Modified Davis classification · 45° field of view:
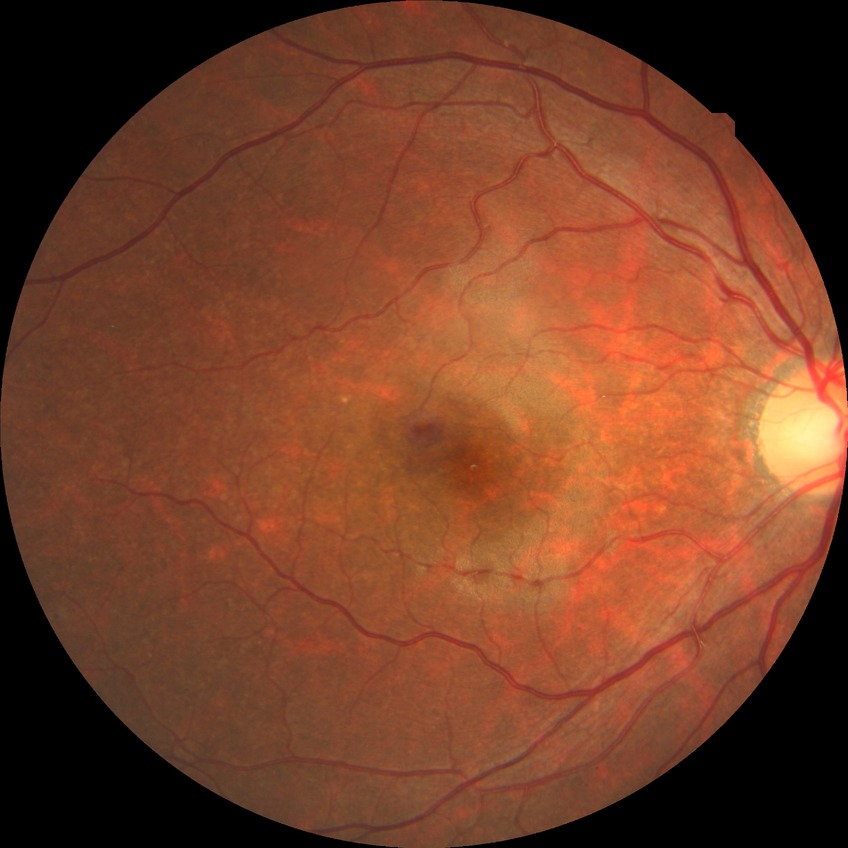
dr_impression: no DR findings
davis_grade: NDR